Color fundus photograph
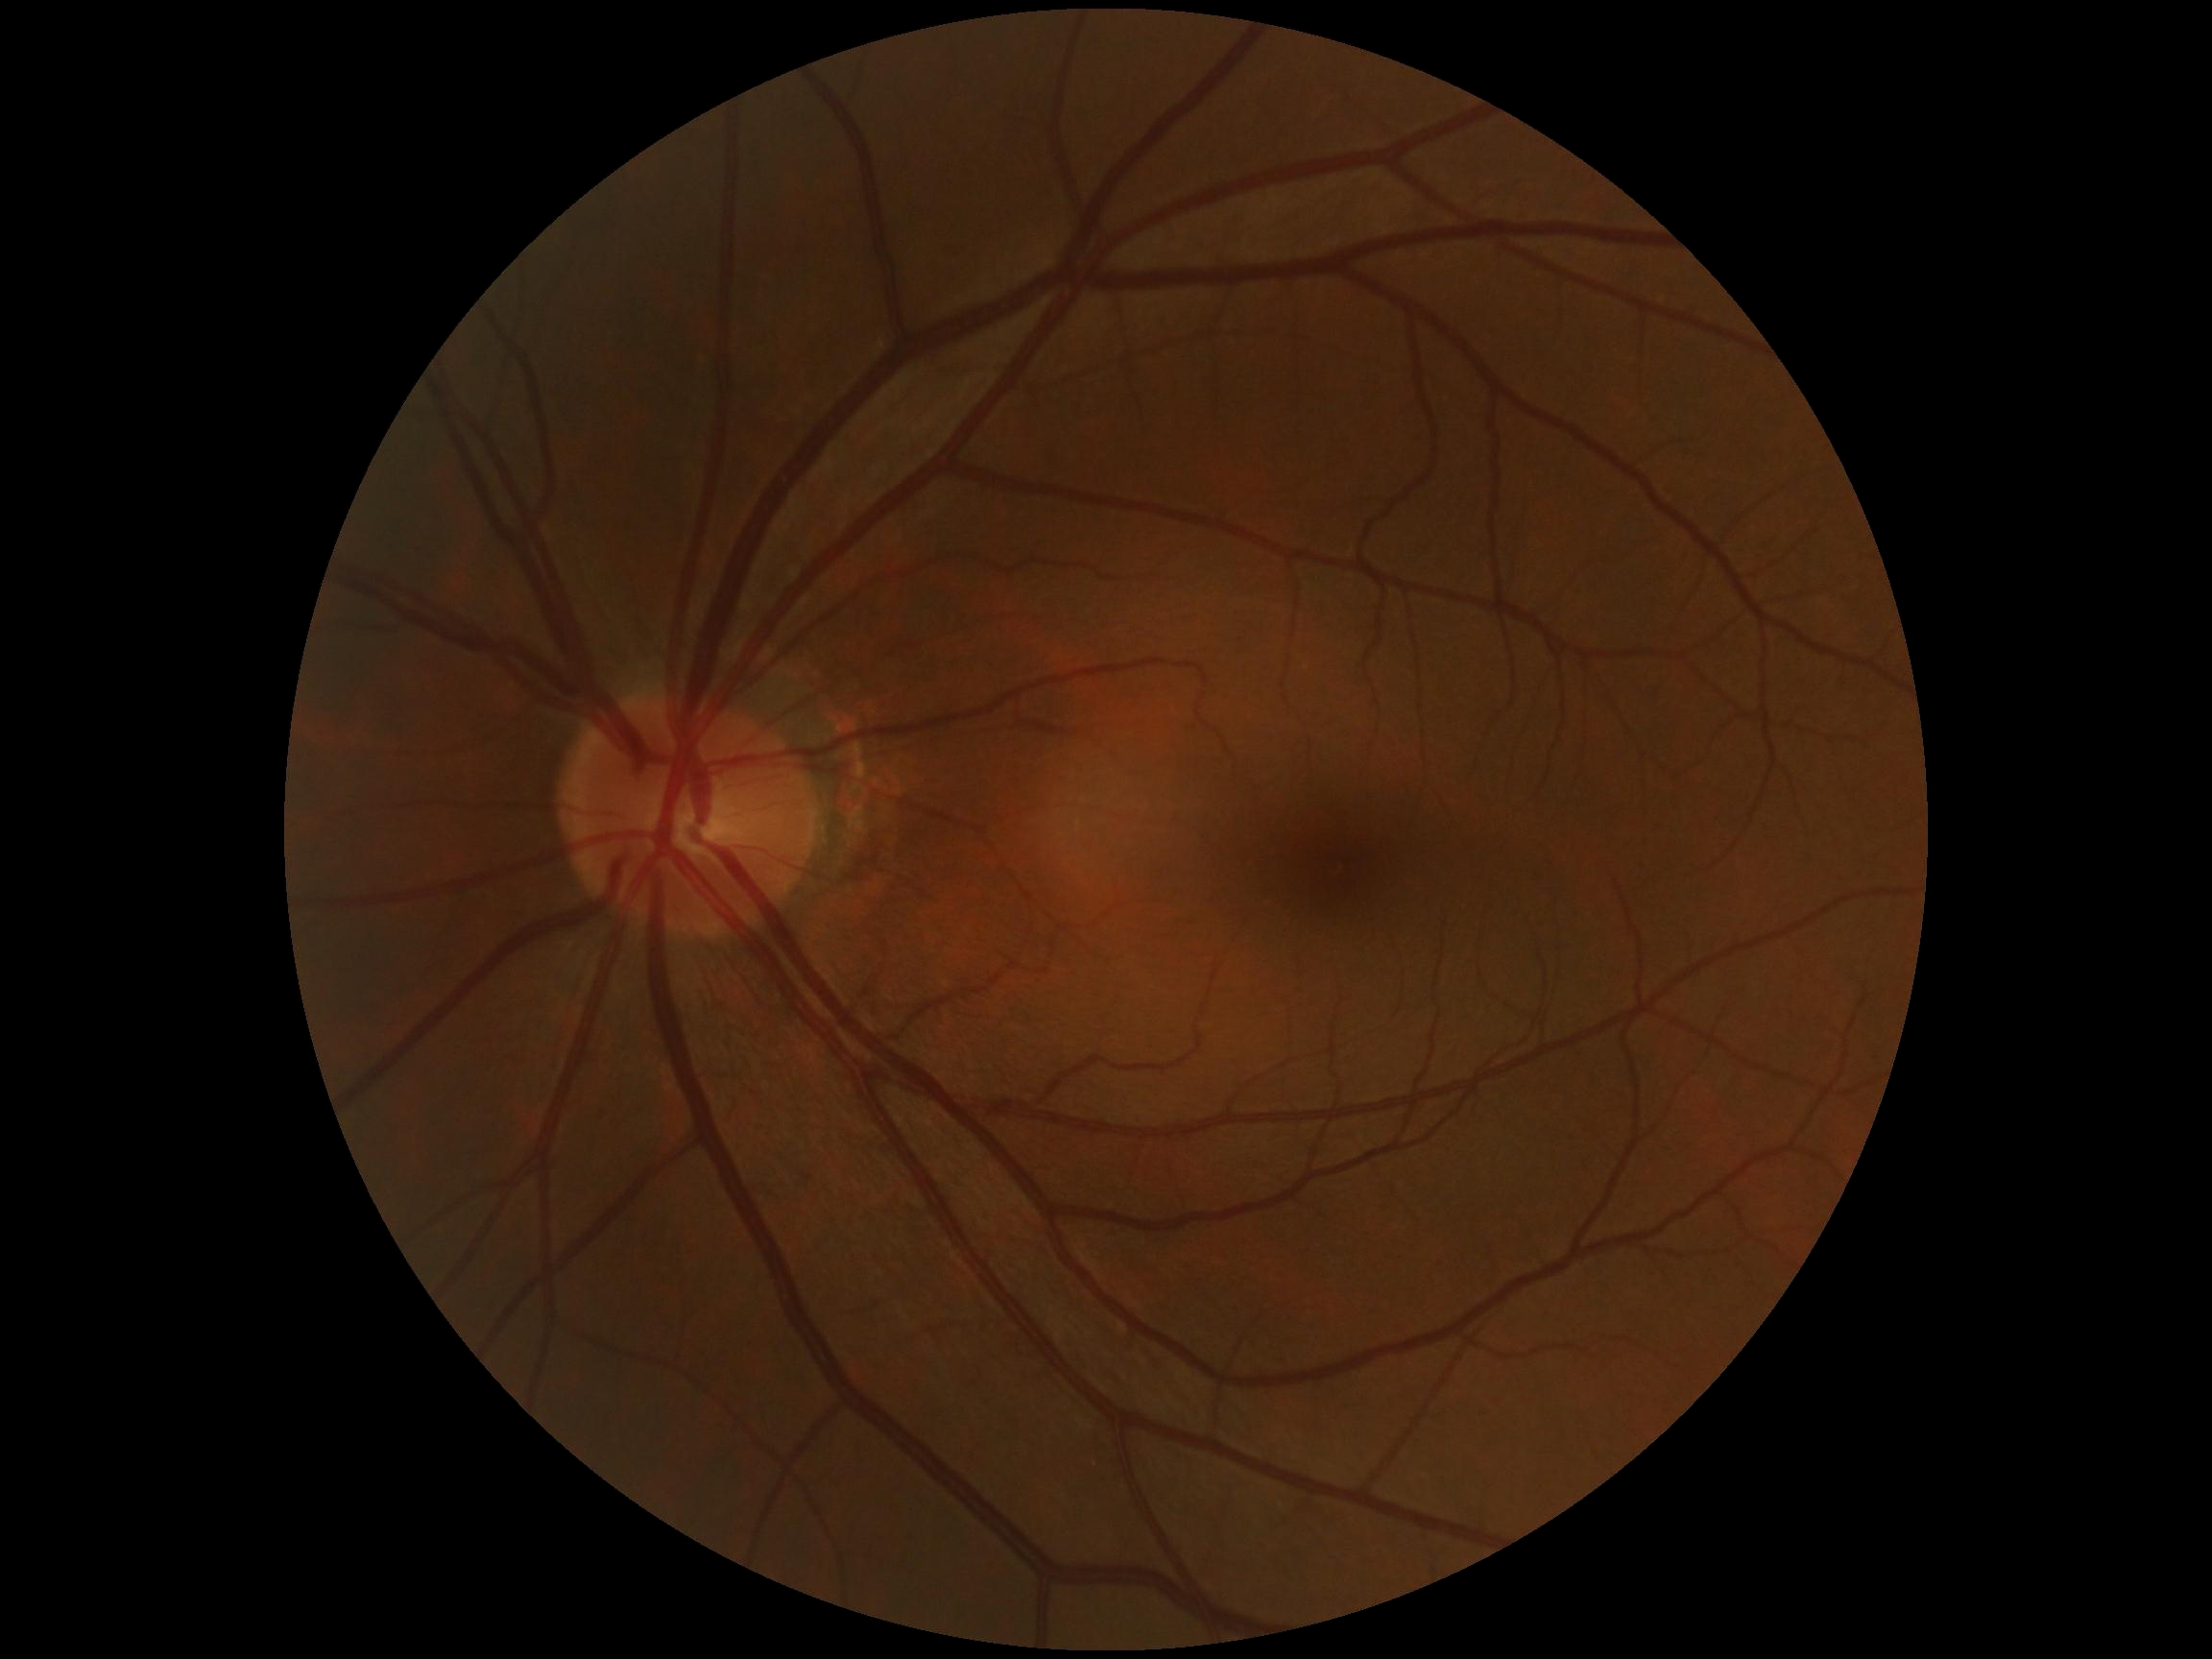 Diabetic retinopathy (DR): grade 0 (no apparent retinopathy) — no visible signs of diabetic retinopathy. No DR findings.